FOV: 45 degrees, color fundus photograph — 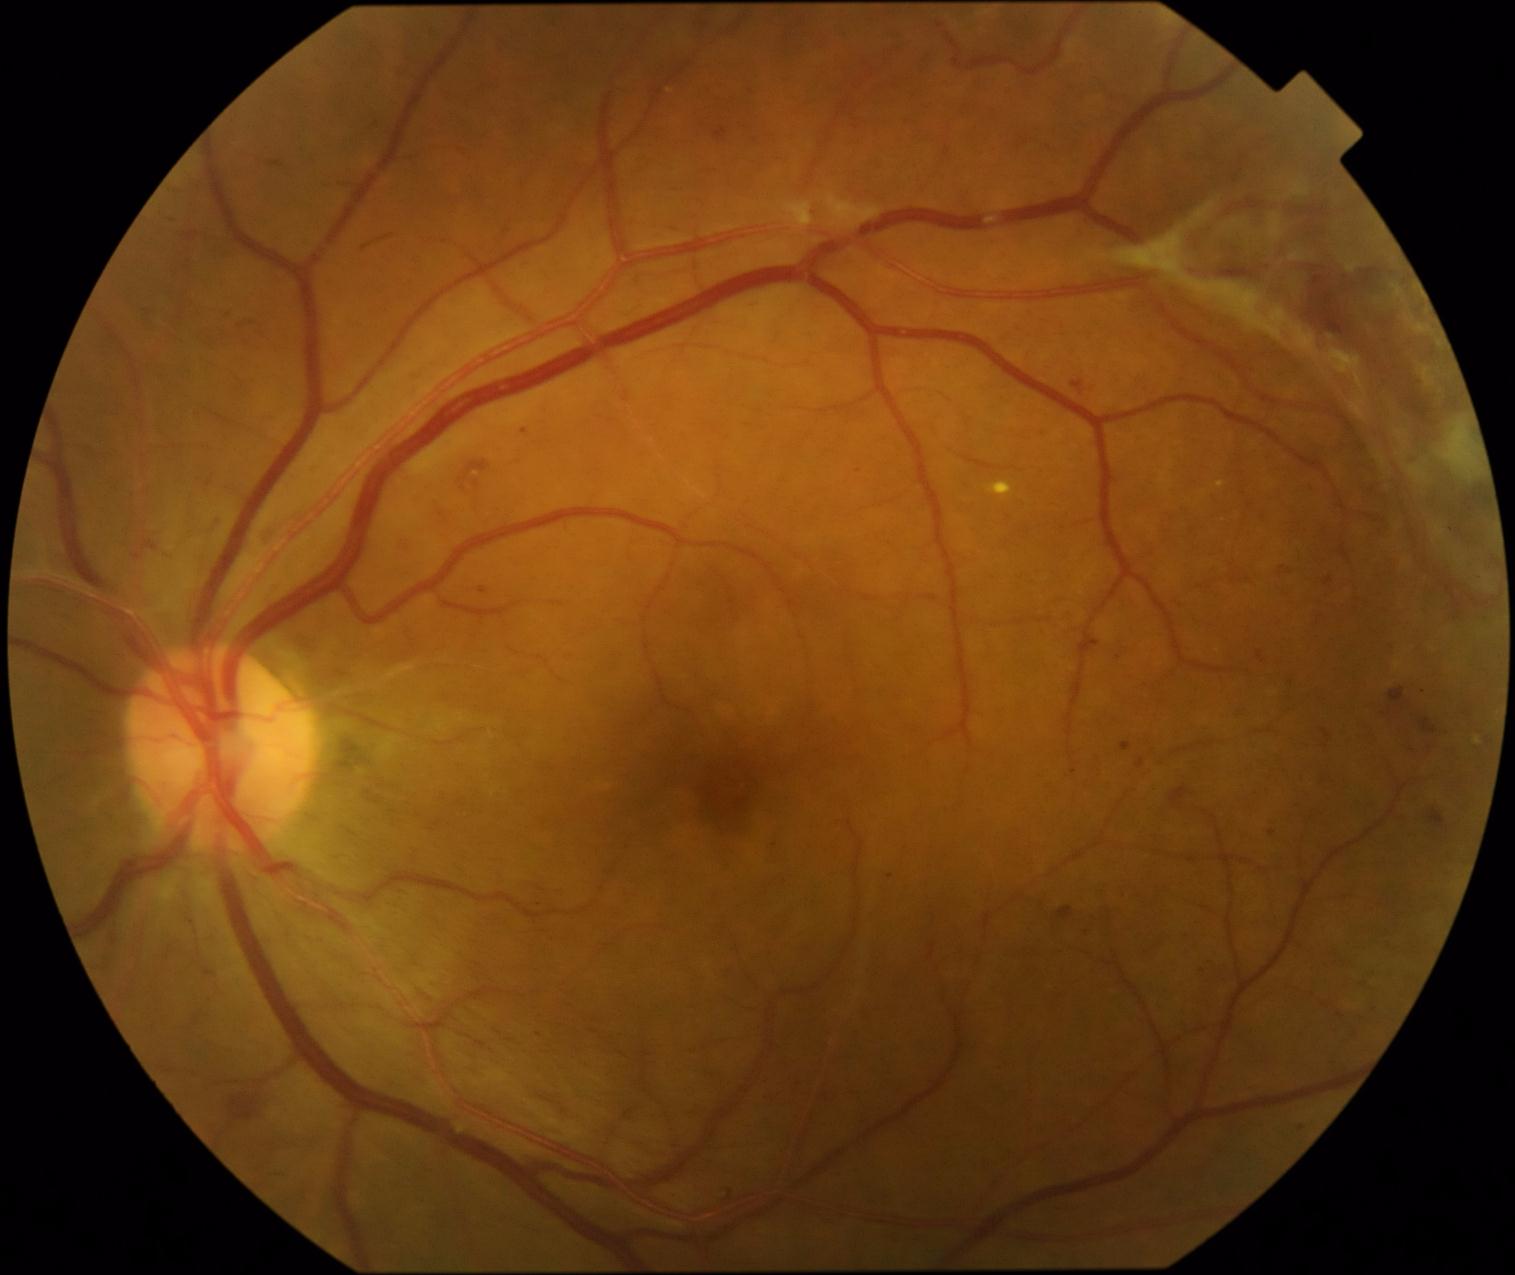
  dr_grade: 4